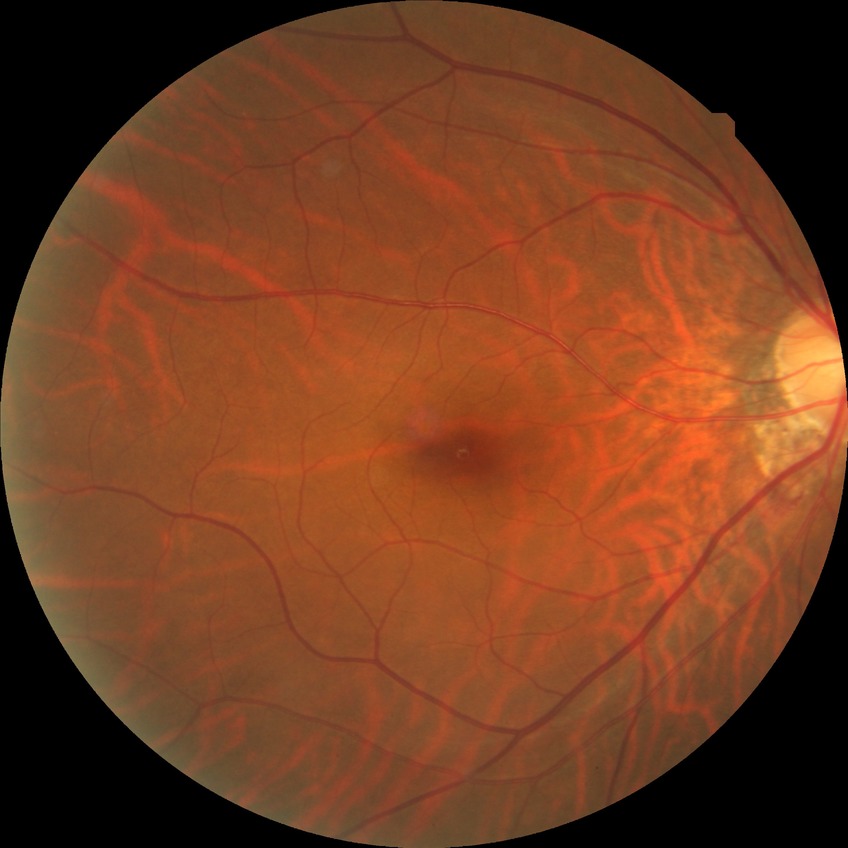
Diabetic retinopathy (DR) is no diabetic retinopathy (NDR).